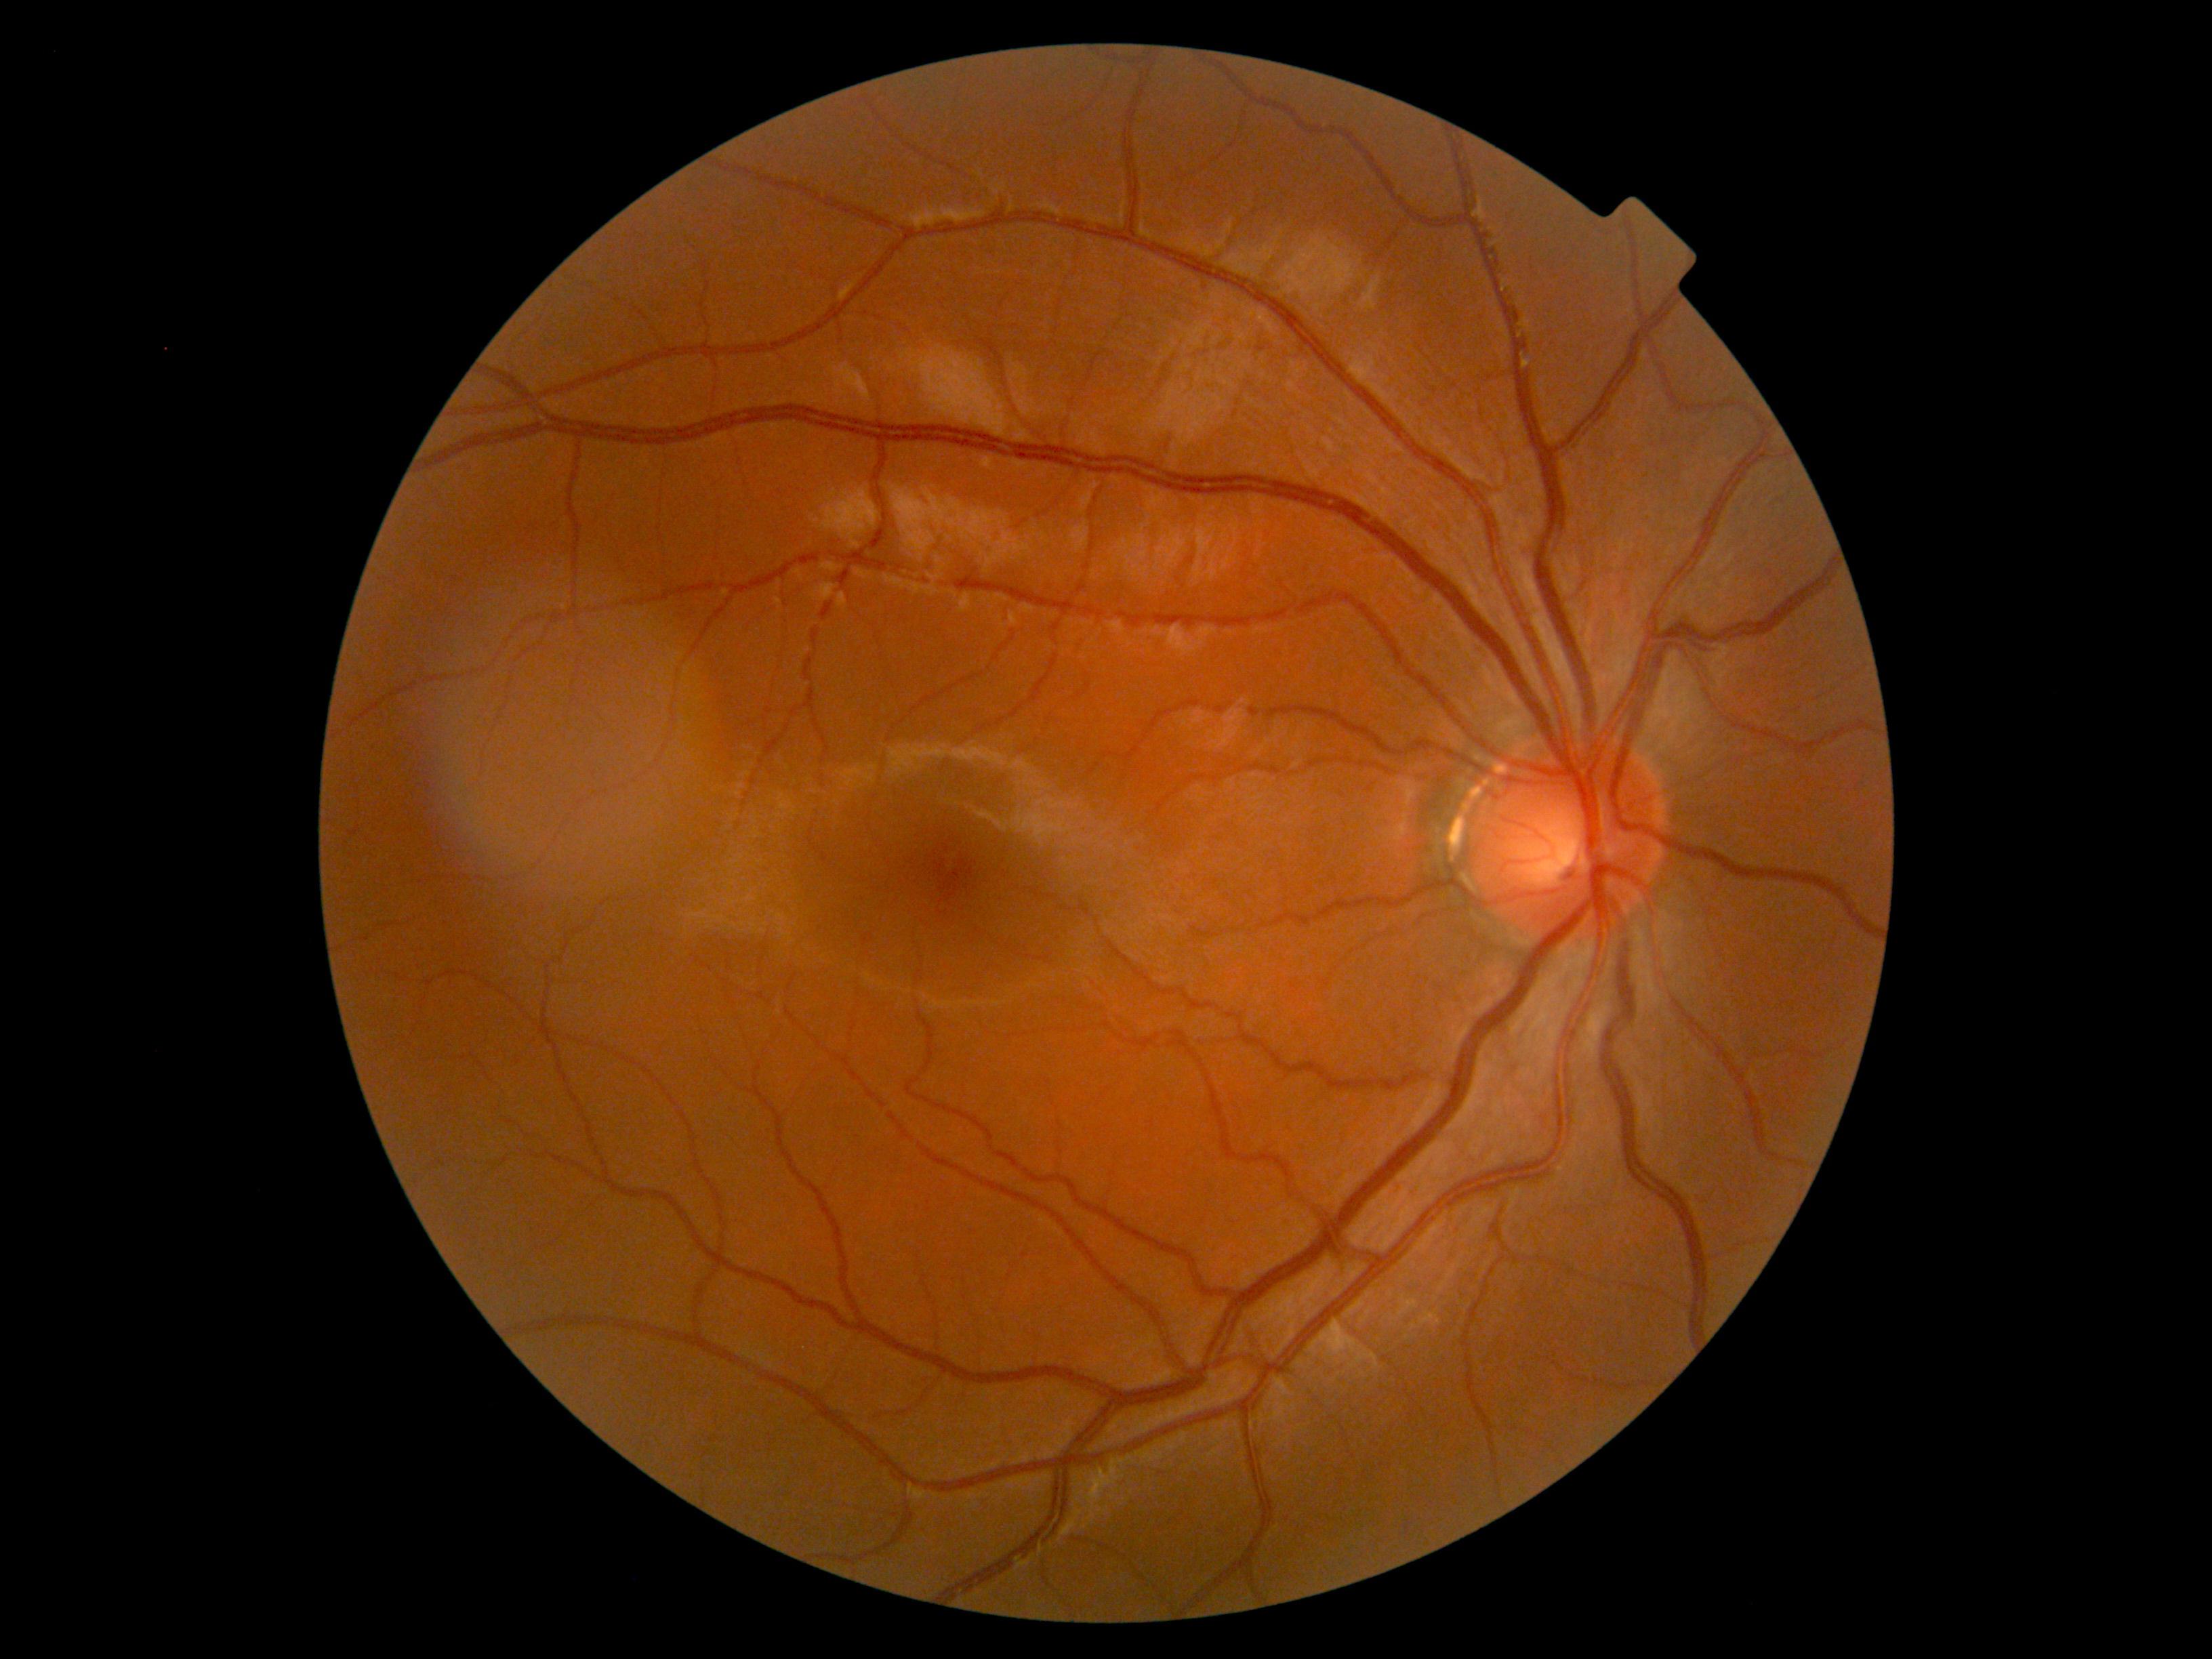 * DR impression: negative for DR
* DR severity: grade 0 (no apparent retinopathy)